2352 by 1568 pixels
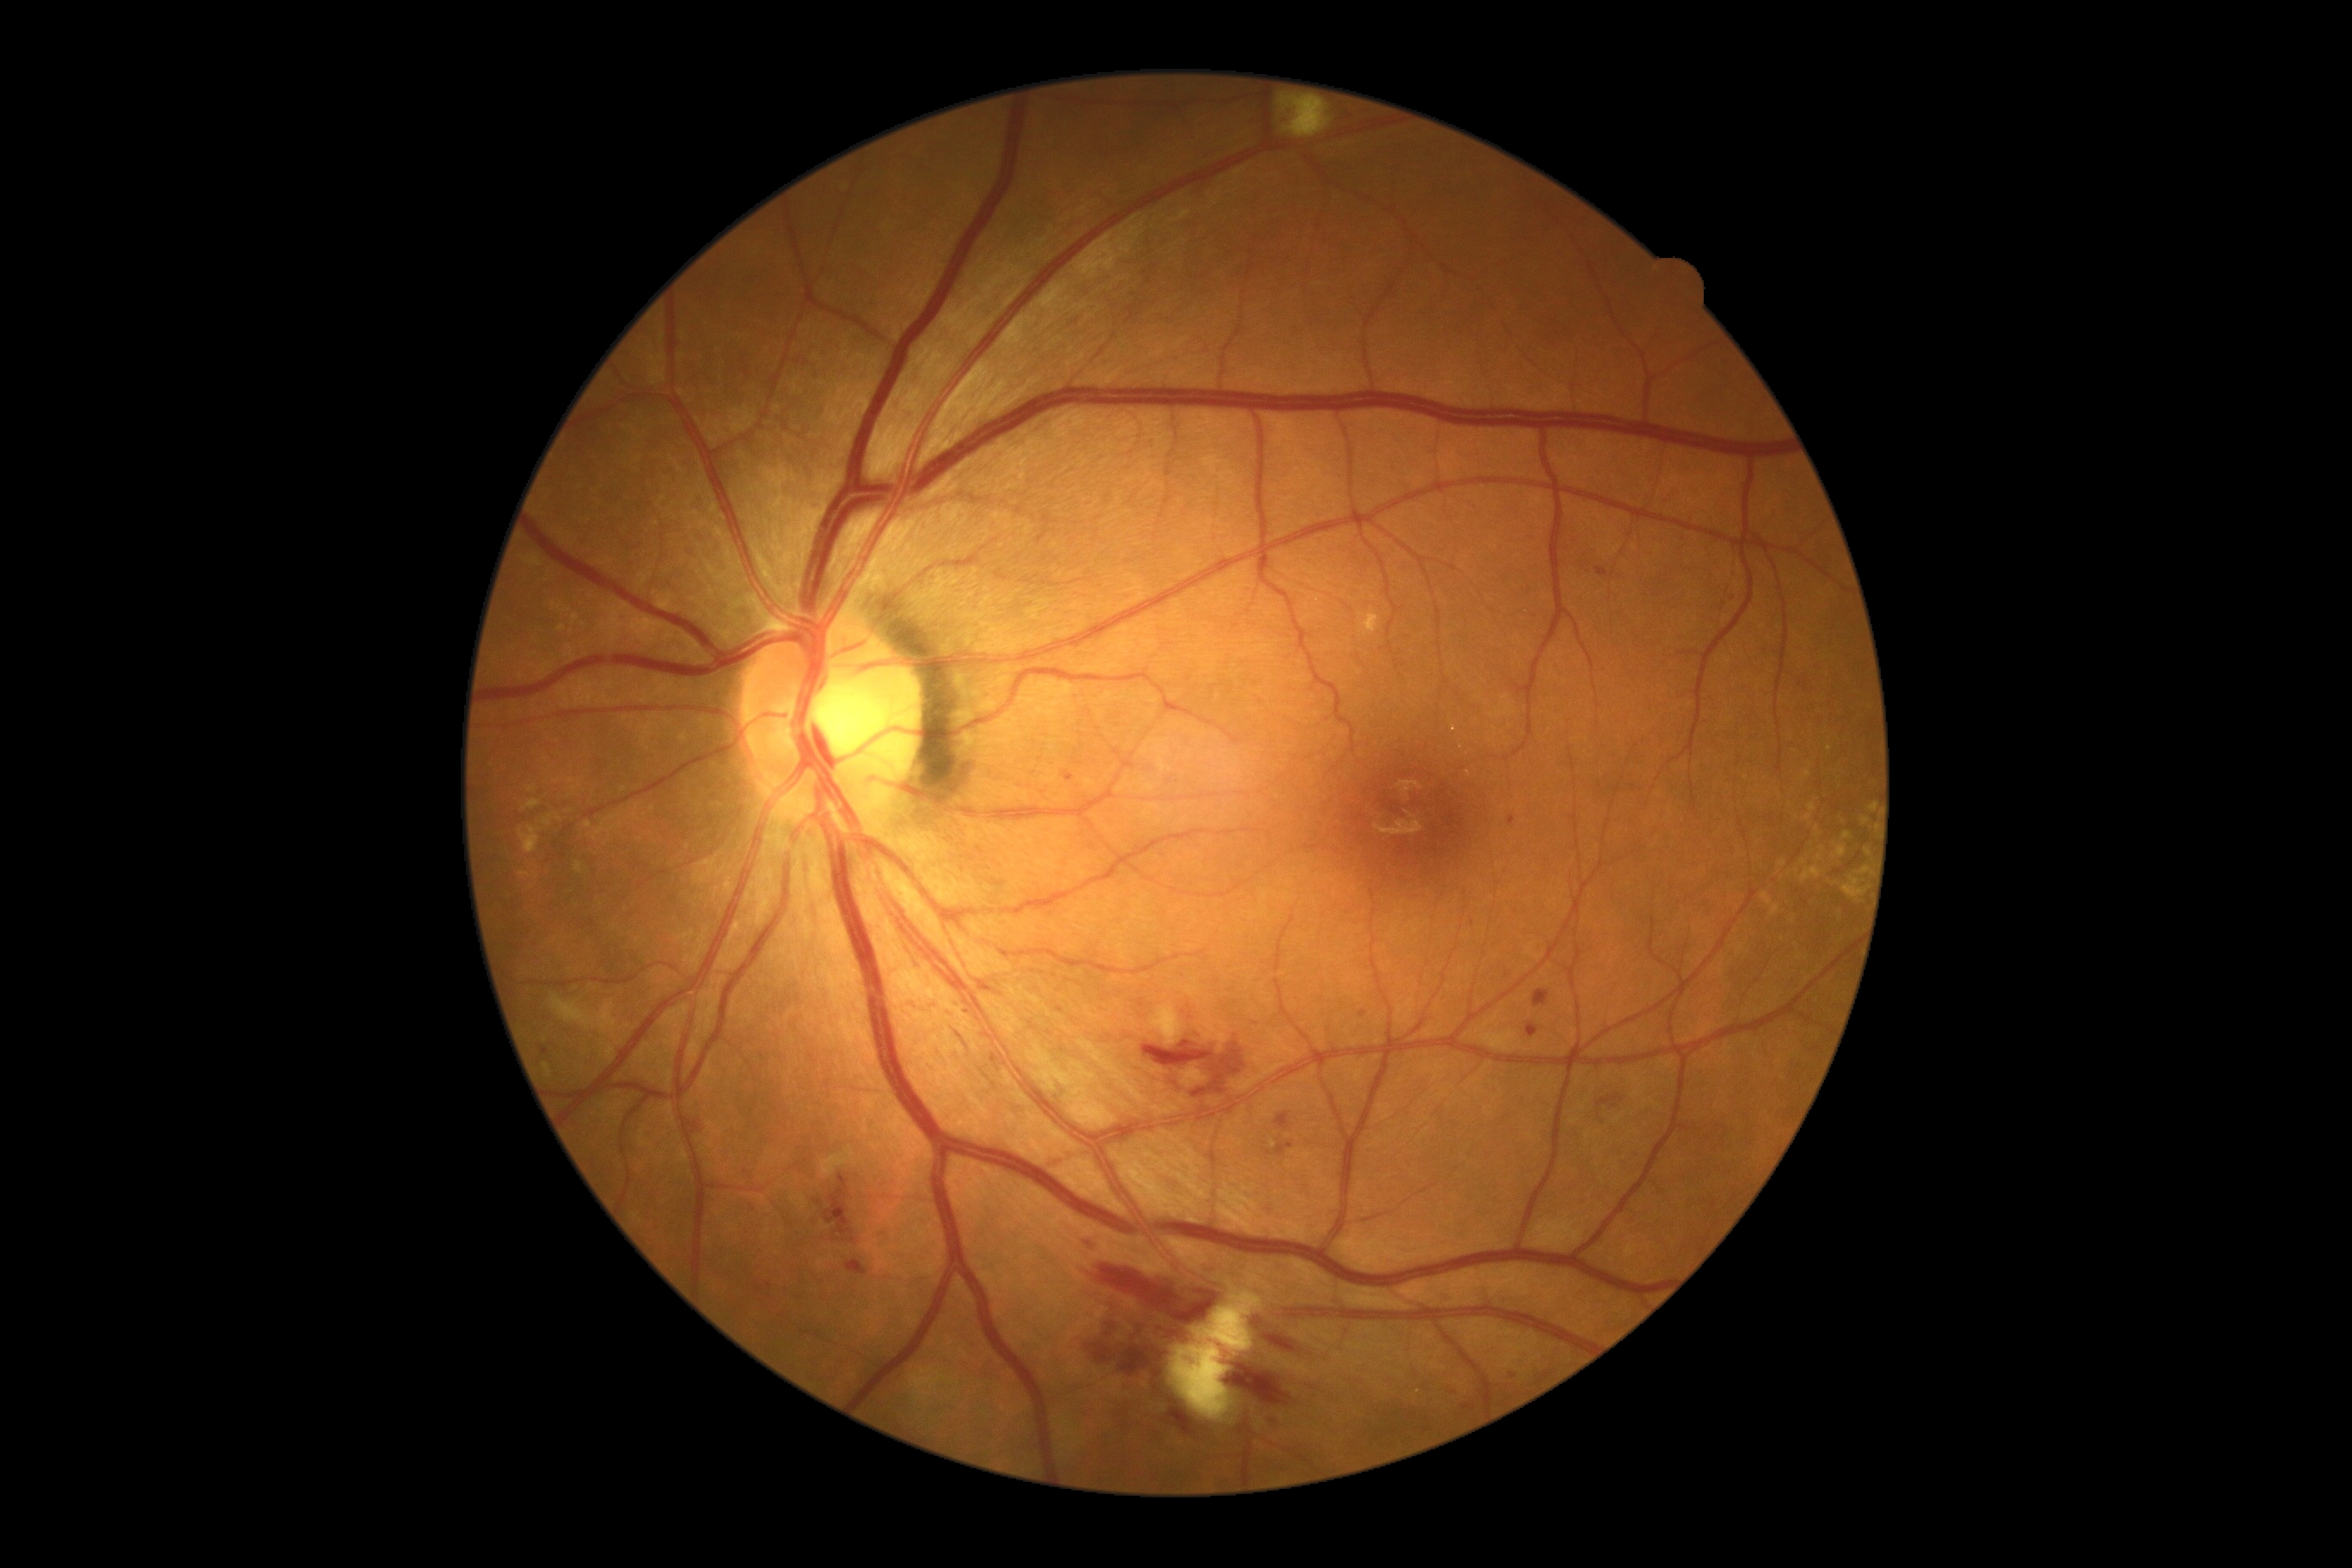

DR is grade 2 (moderate NPDR) — more than just microaneurysms but less than severe NPDR.